45° FOV · CFP
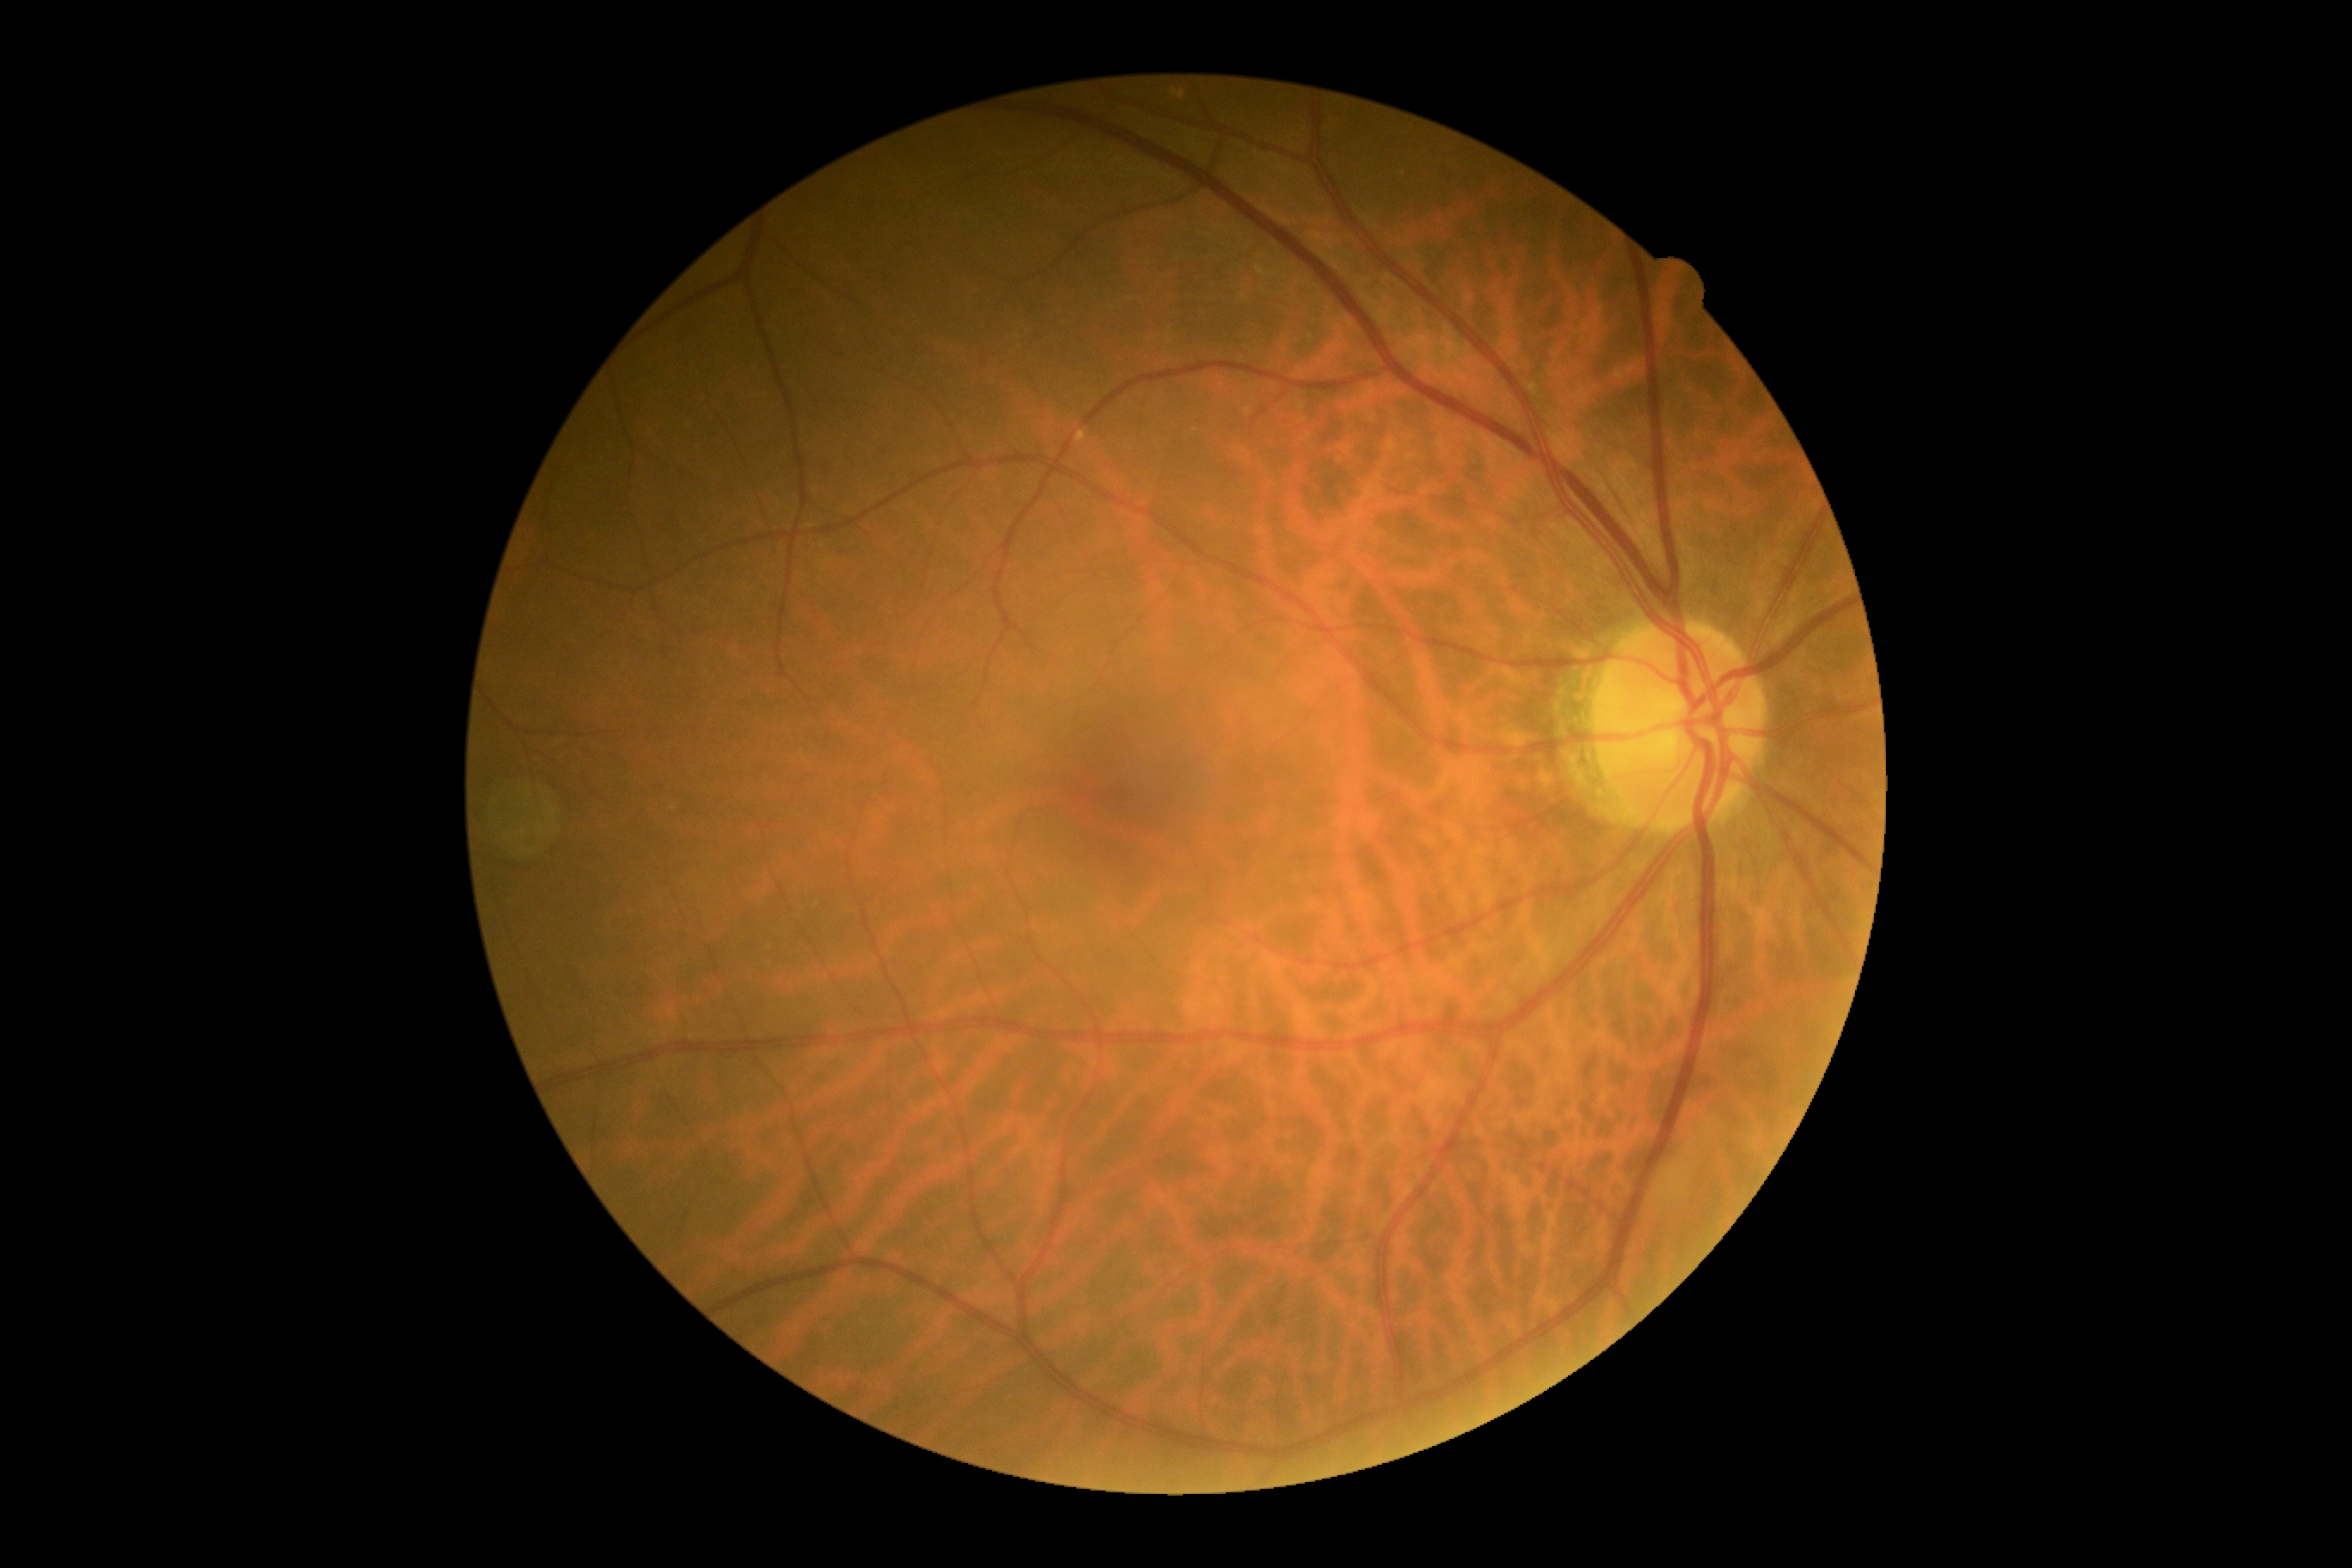
Retinopathy is grade 0 (no apparent retinopathy).